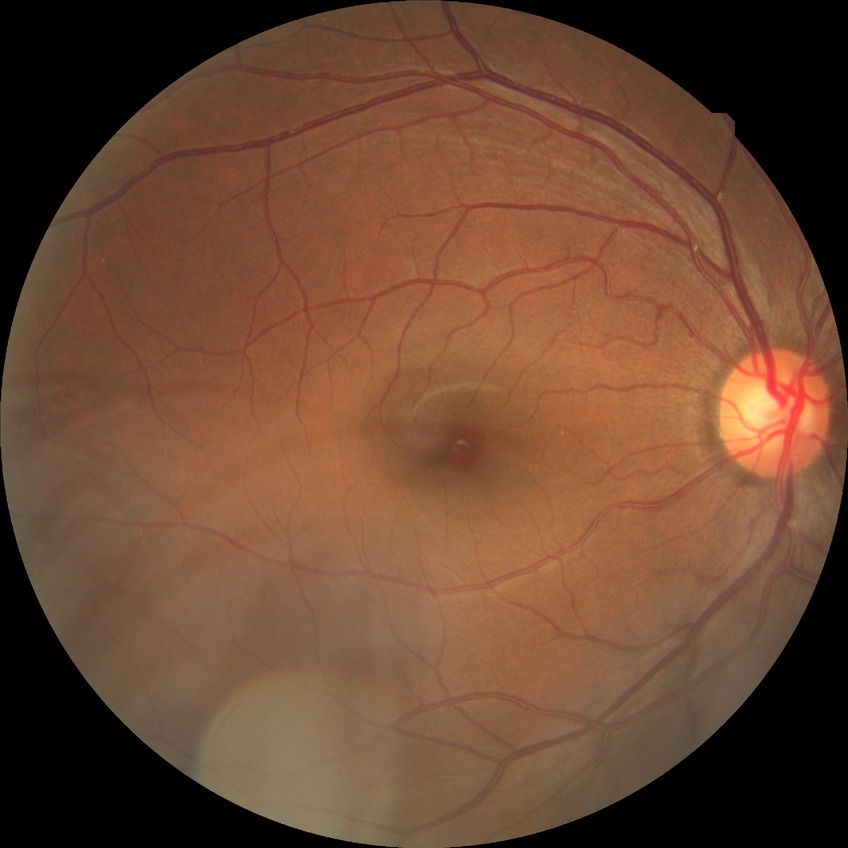 DR grade = NDR; DR impression = no apparent DR.